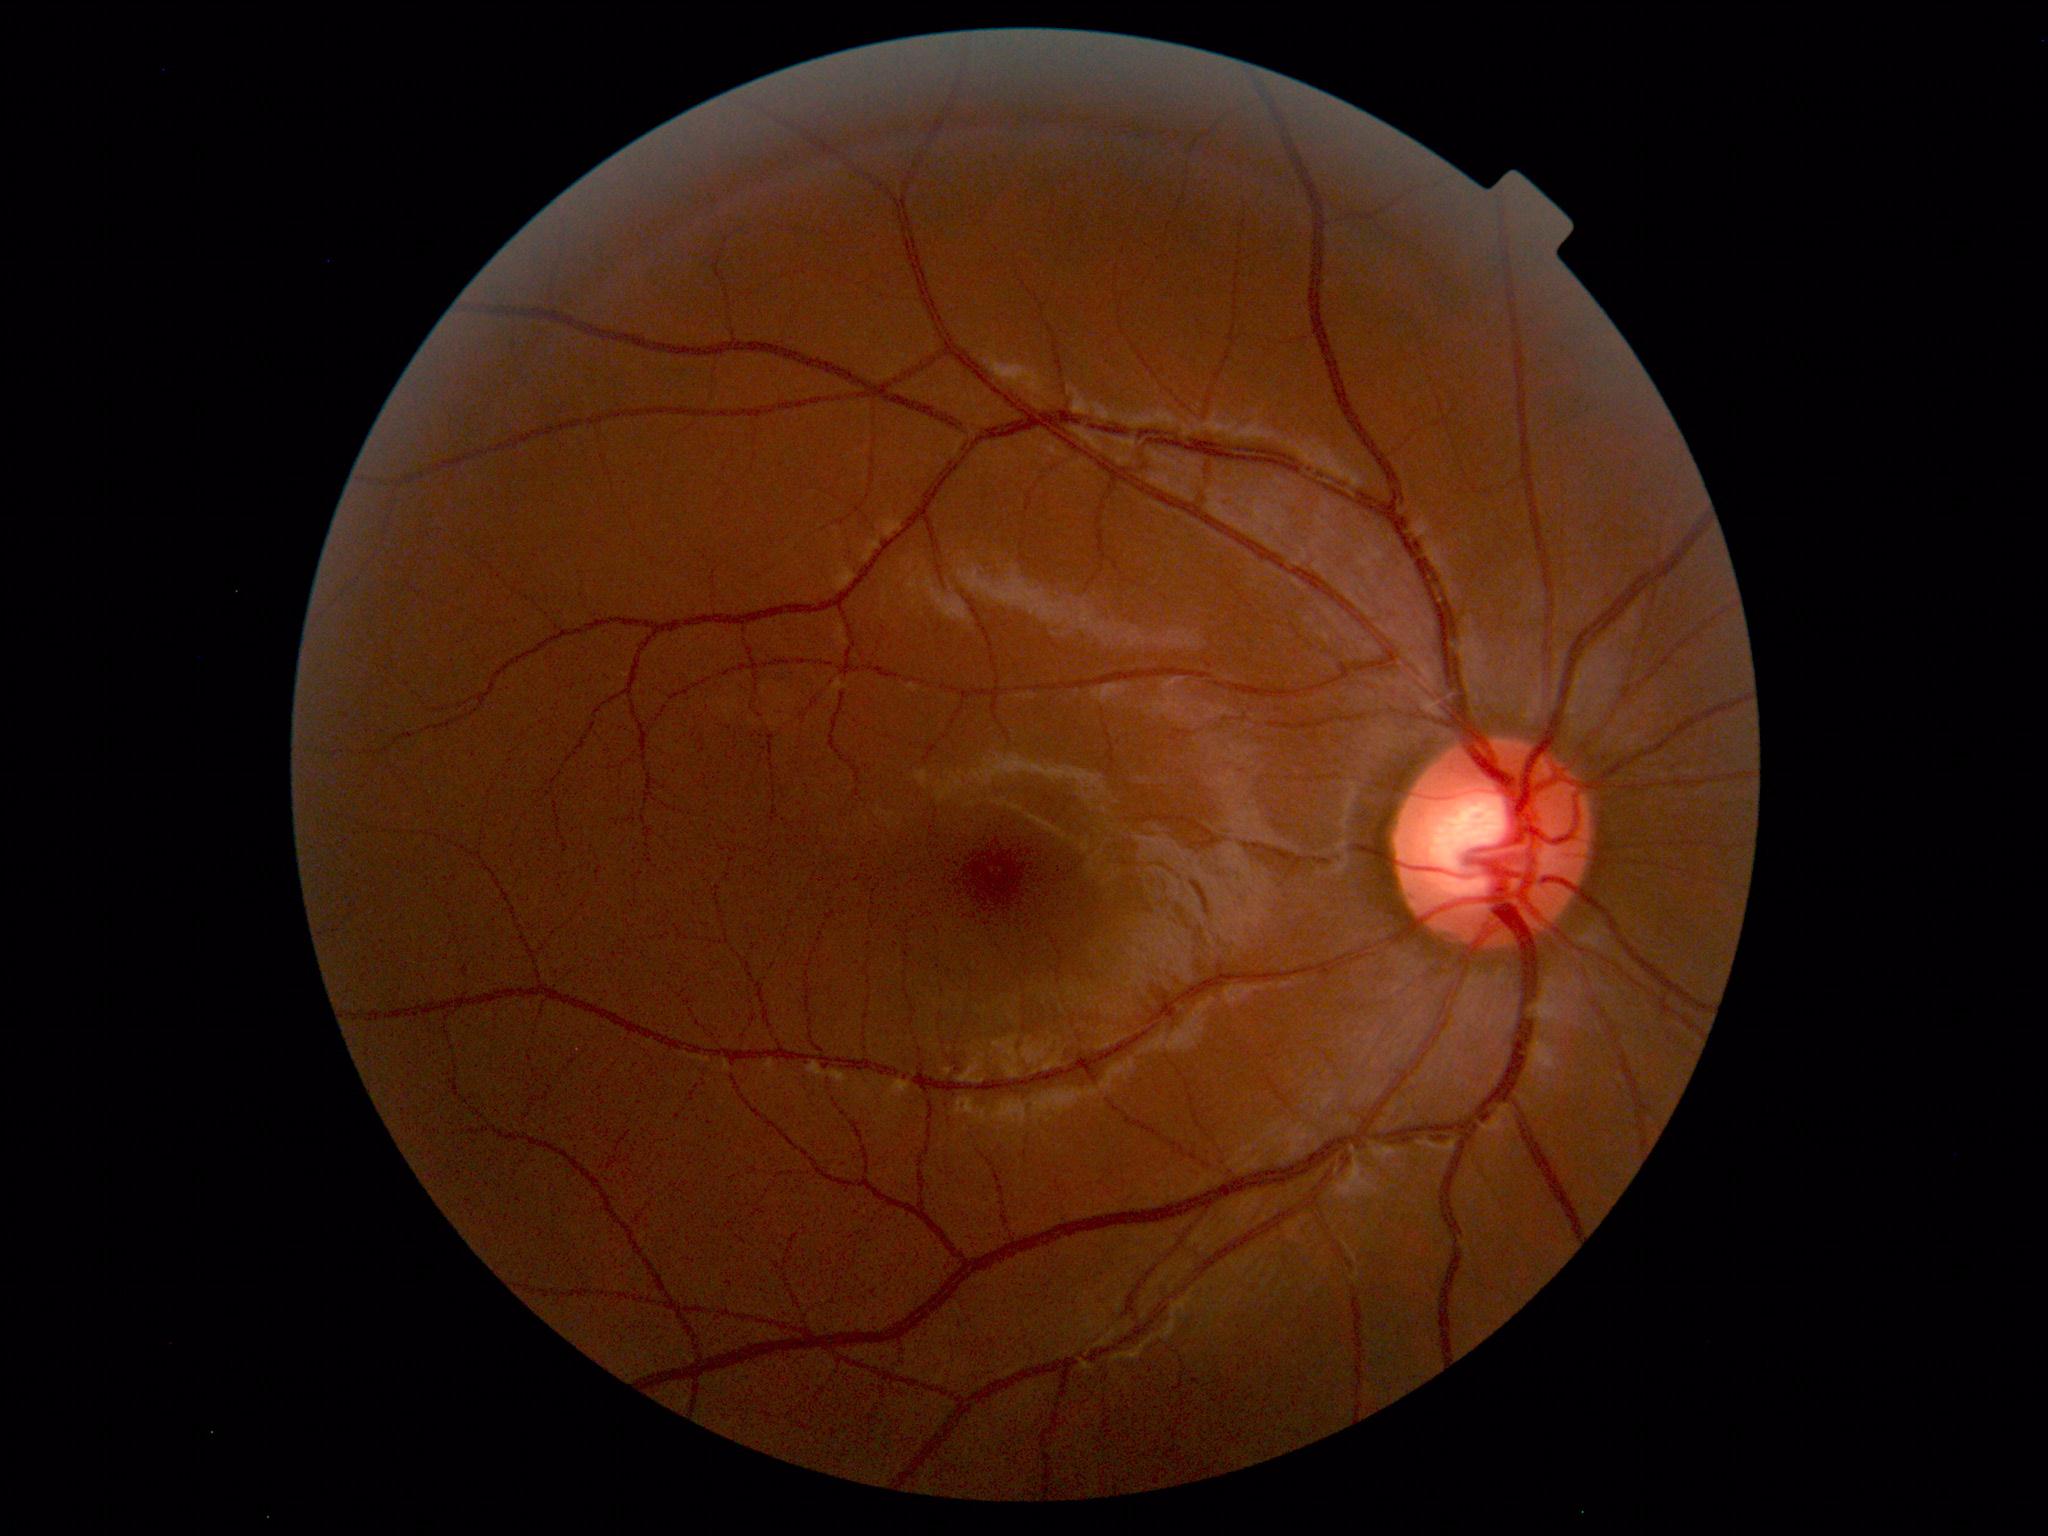 Unremarkable color fundus photograph.